No pharmacologic dilation · 848x848px · NIDEK AFC-230: 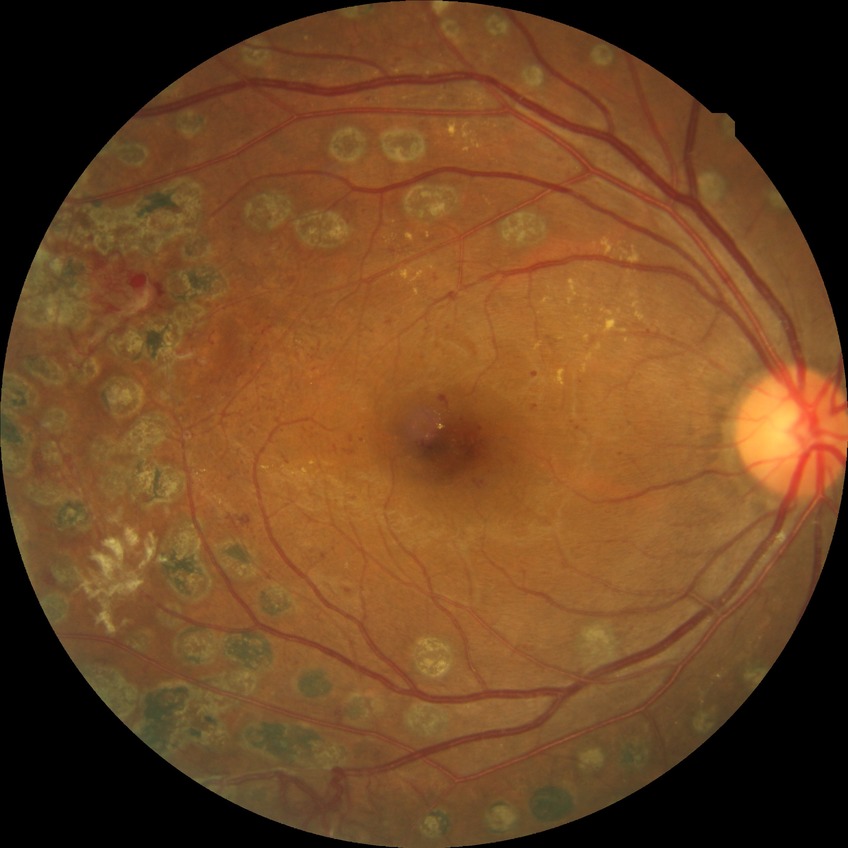

Davis grade is PDR.